Modified Davis classification:
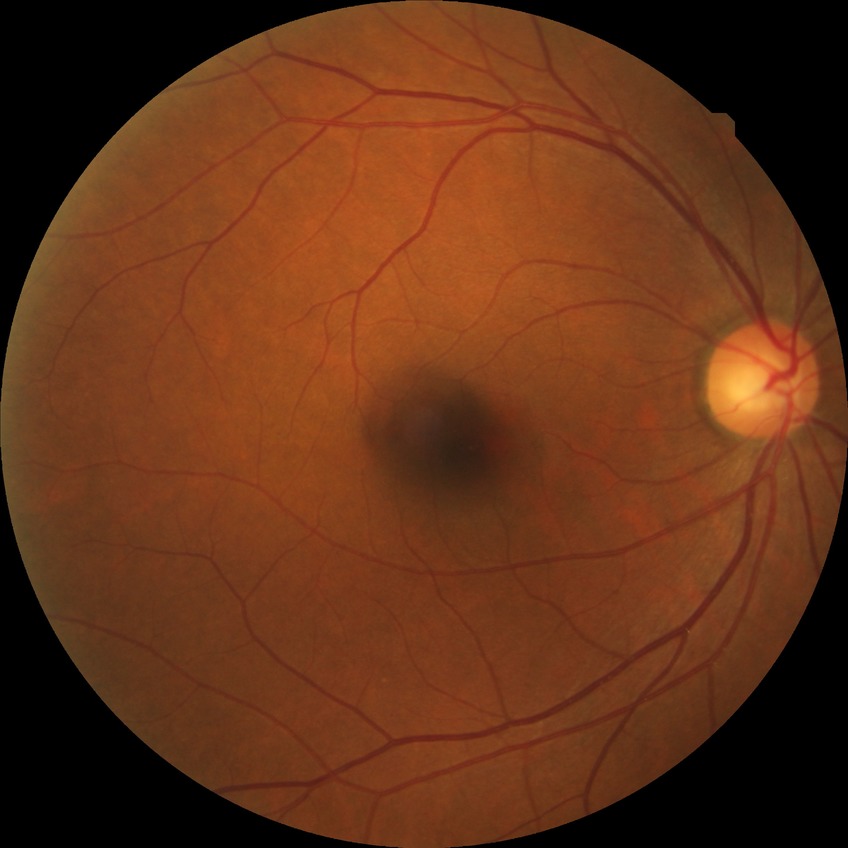
DR is SDR.